FOV: 50 degrees, color fundus image, Kowa VX-10α, macula at the center of the field, 2361x1568.
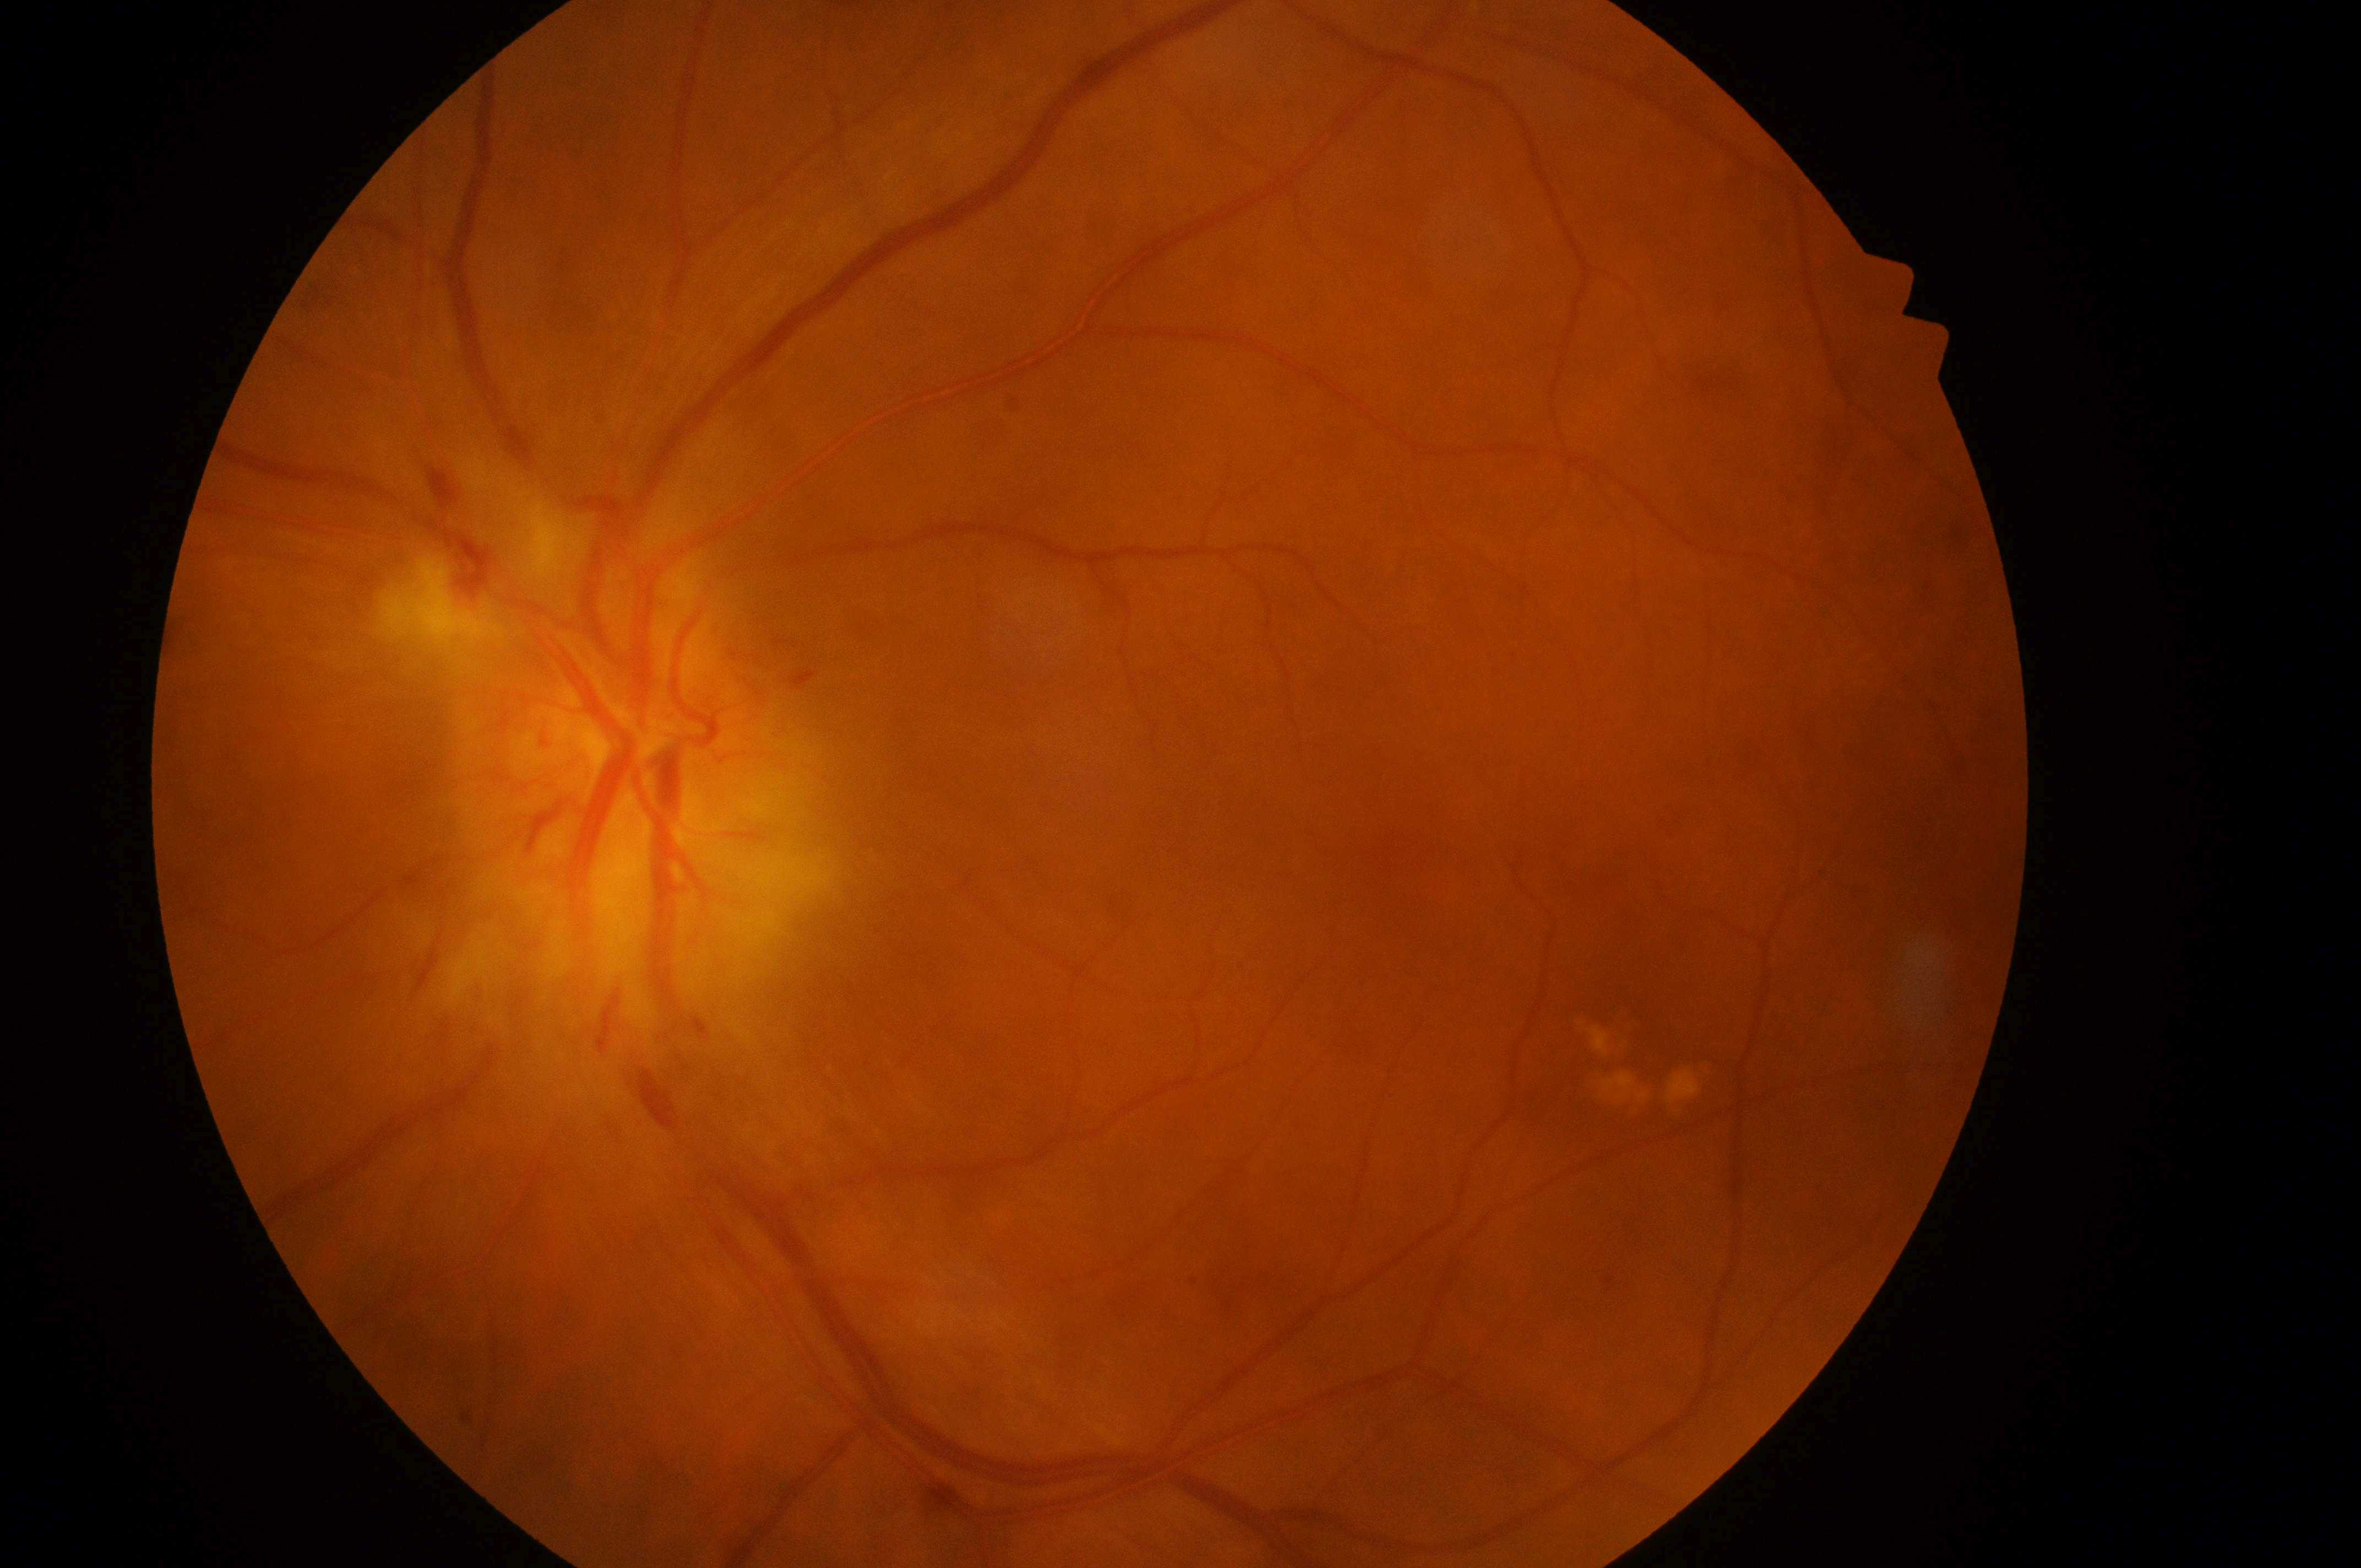
Annotations:
* fovea centralis · 1413px, 876px
* optic nerve head · 606px, 756px
* DME grade · 0/2
* DR stage · grade 4
* laterality · left eye